Ultra-widefield fundus photograph · 1924 x 1556 pixels:
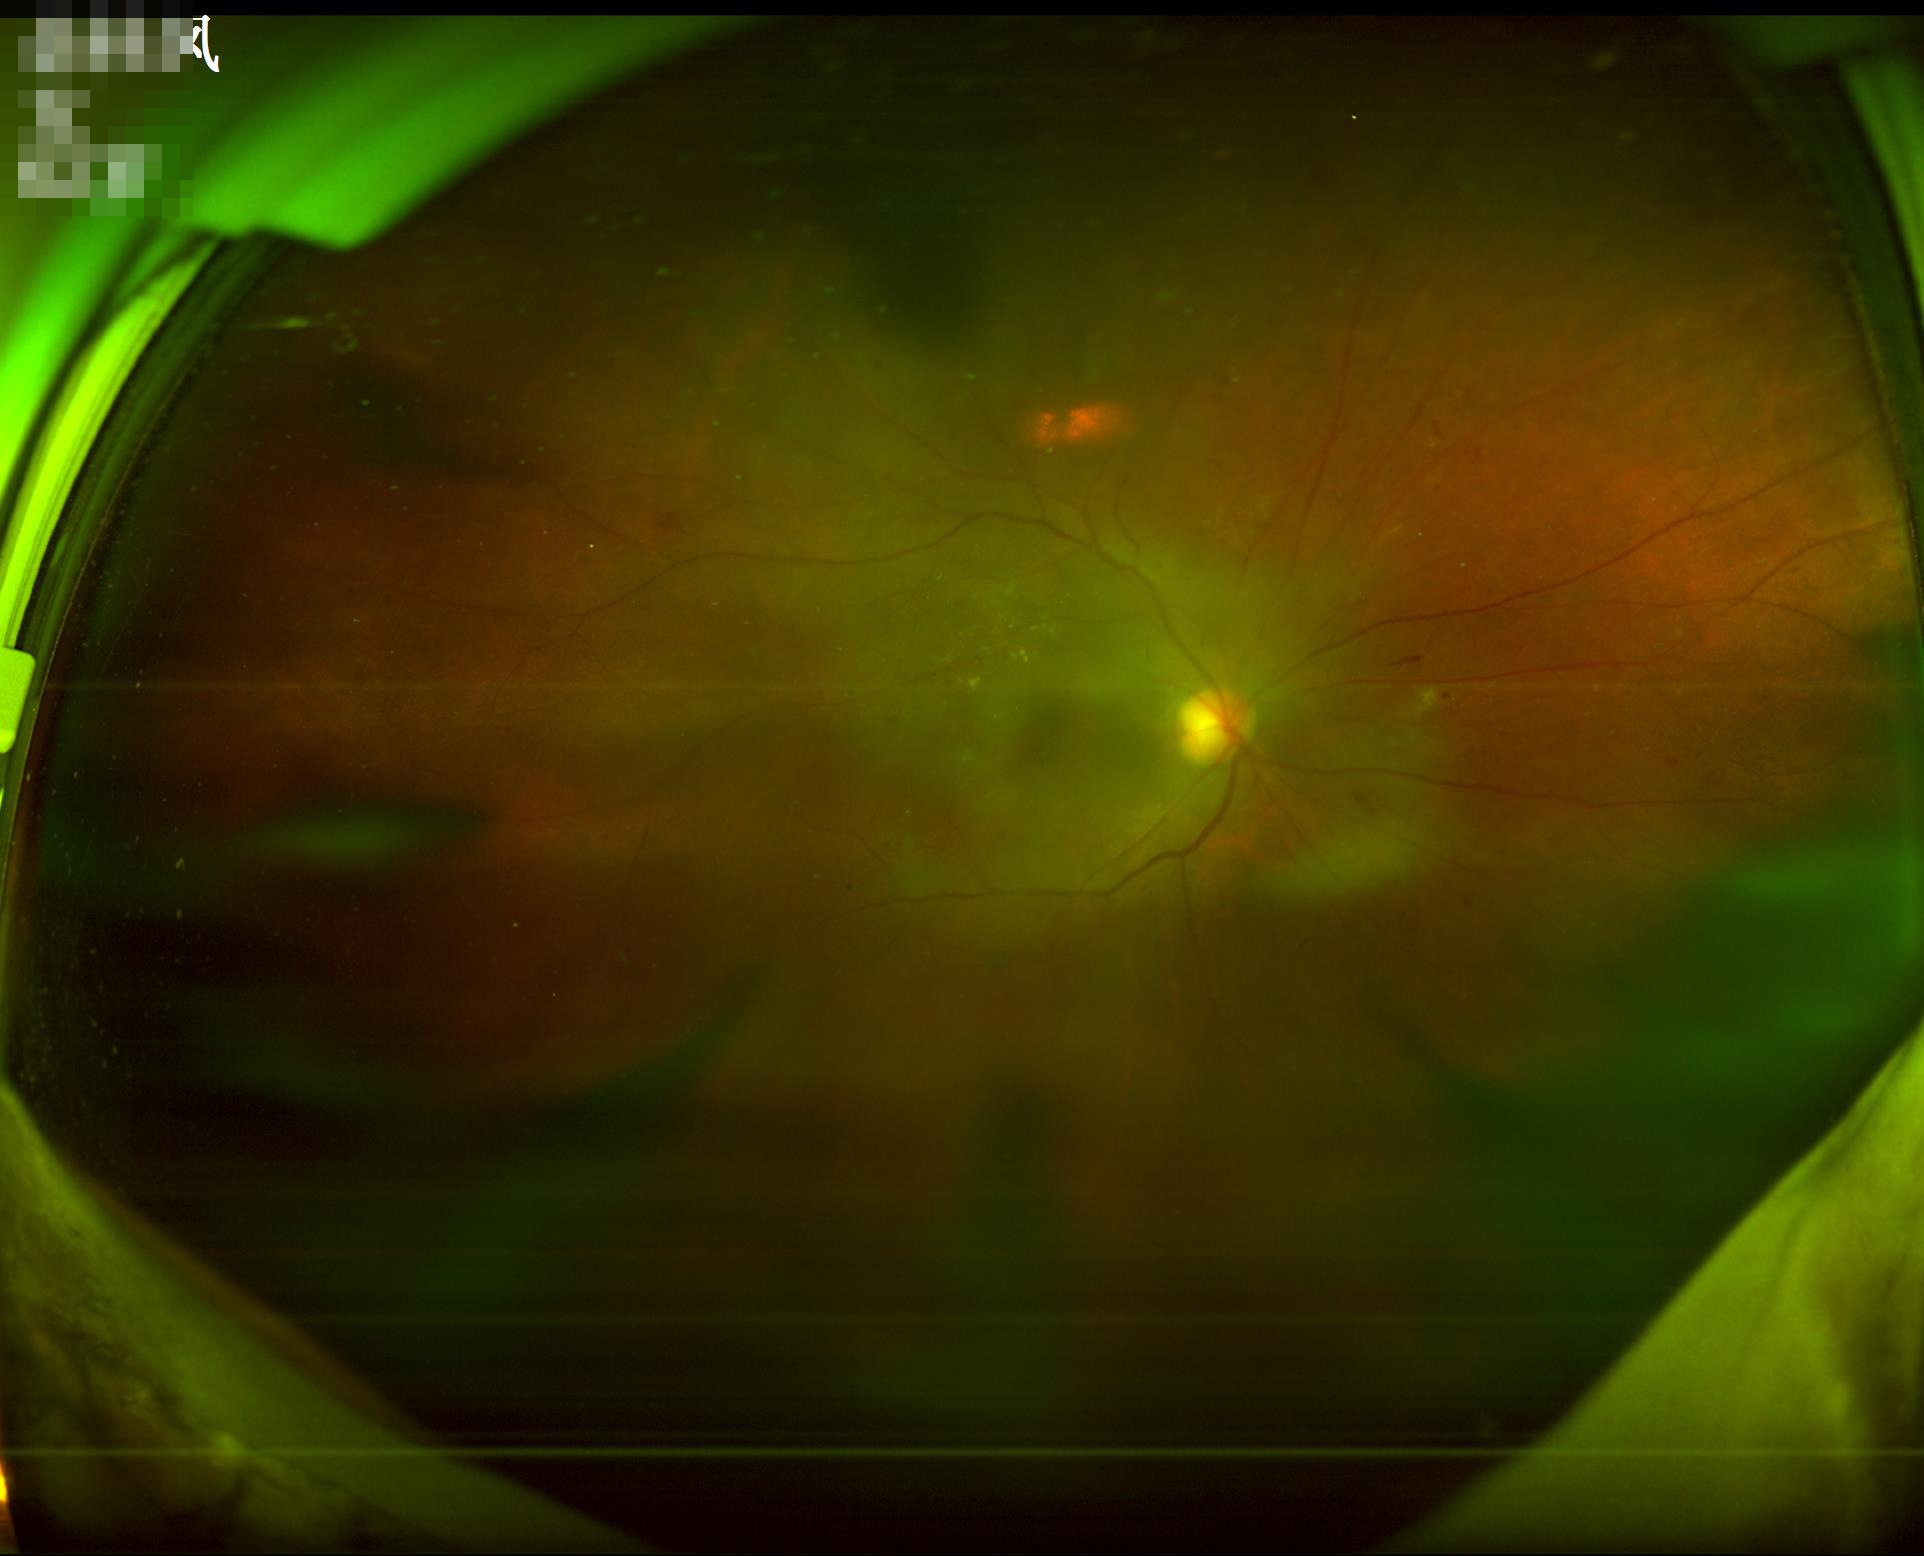 Vessels and details are readily distinguishable. Image quality is inadequate for diagnostic use. Noticeable blur in the optic disc, vessels, or background.